1380 by 1382 pixels; FOV: 45 degrees — 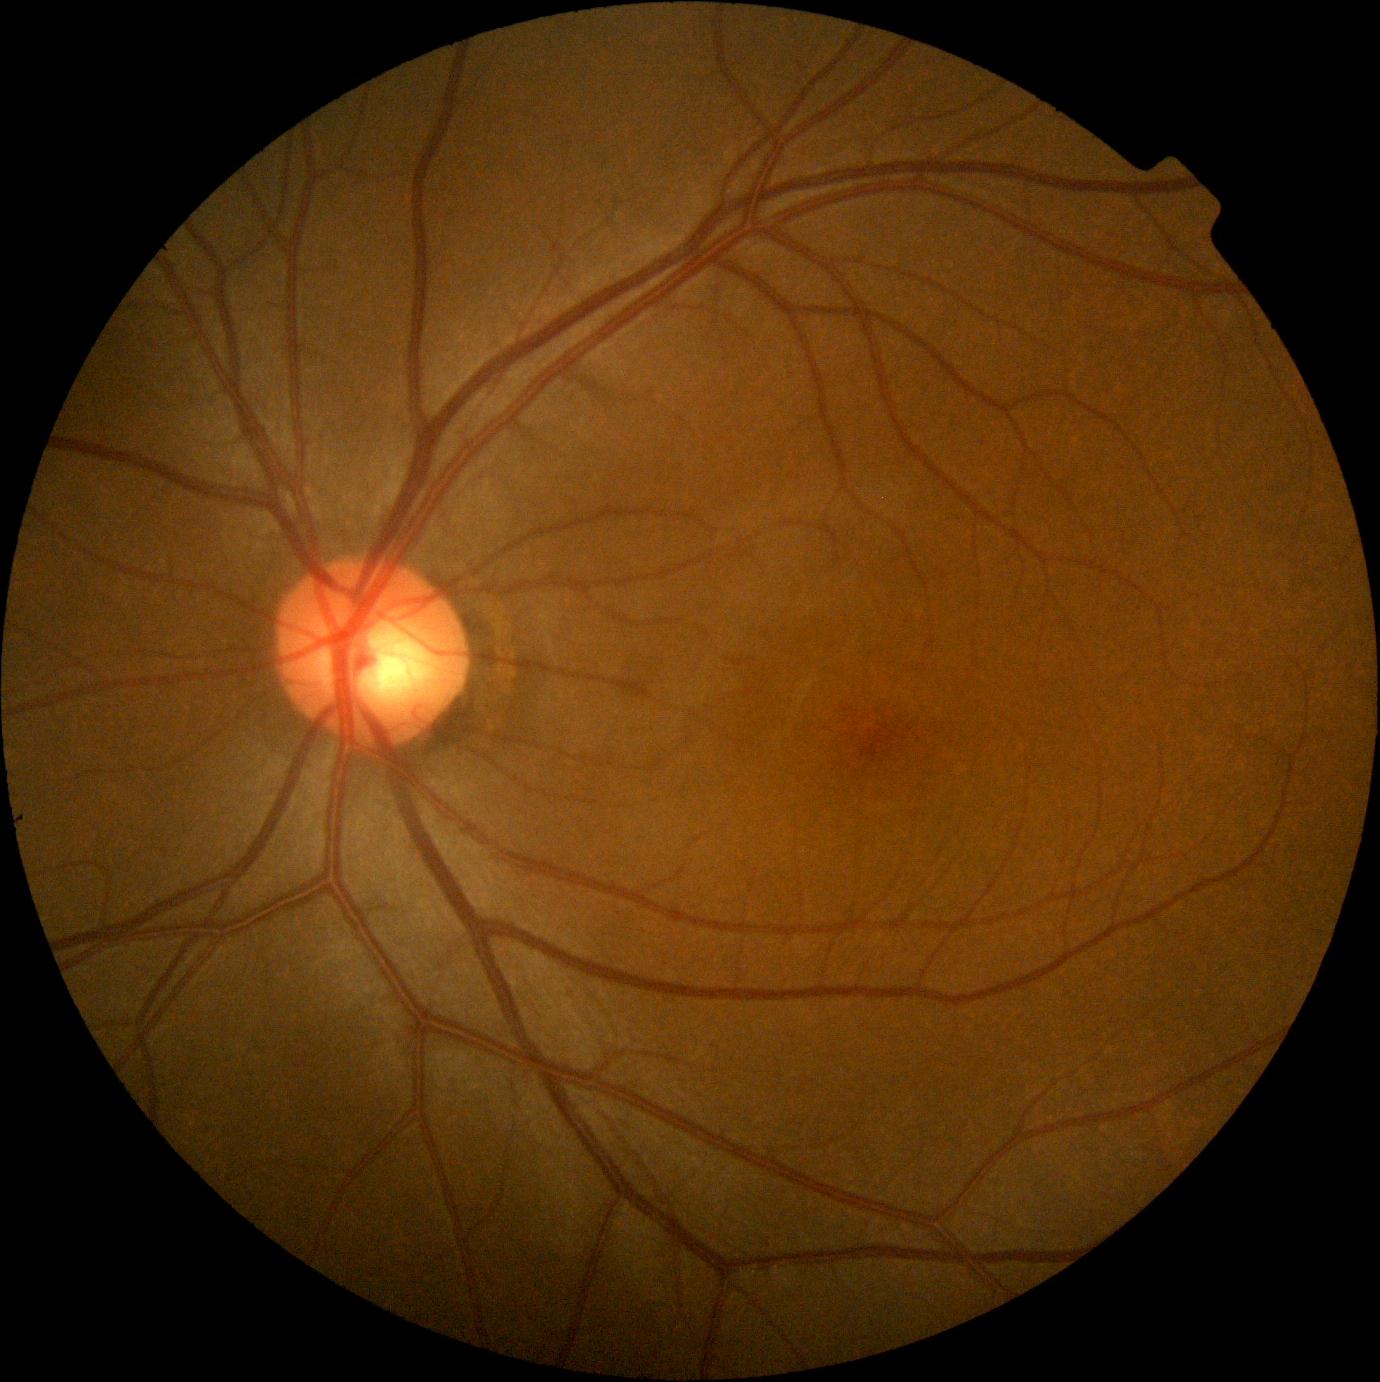

Diabetic retinopathy (DR): no apparent diabetic retinopathy (grade 0).